Posterior pole field covering the optic disc and macula; camera: Topcon TRC-50DX: 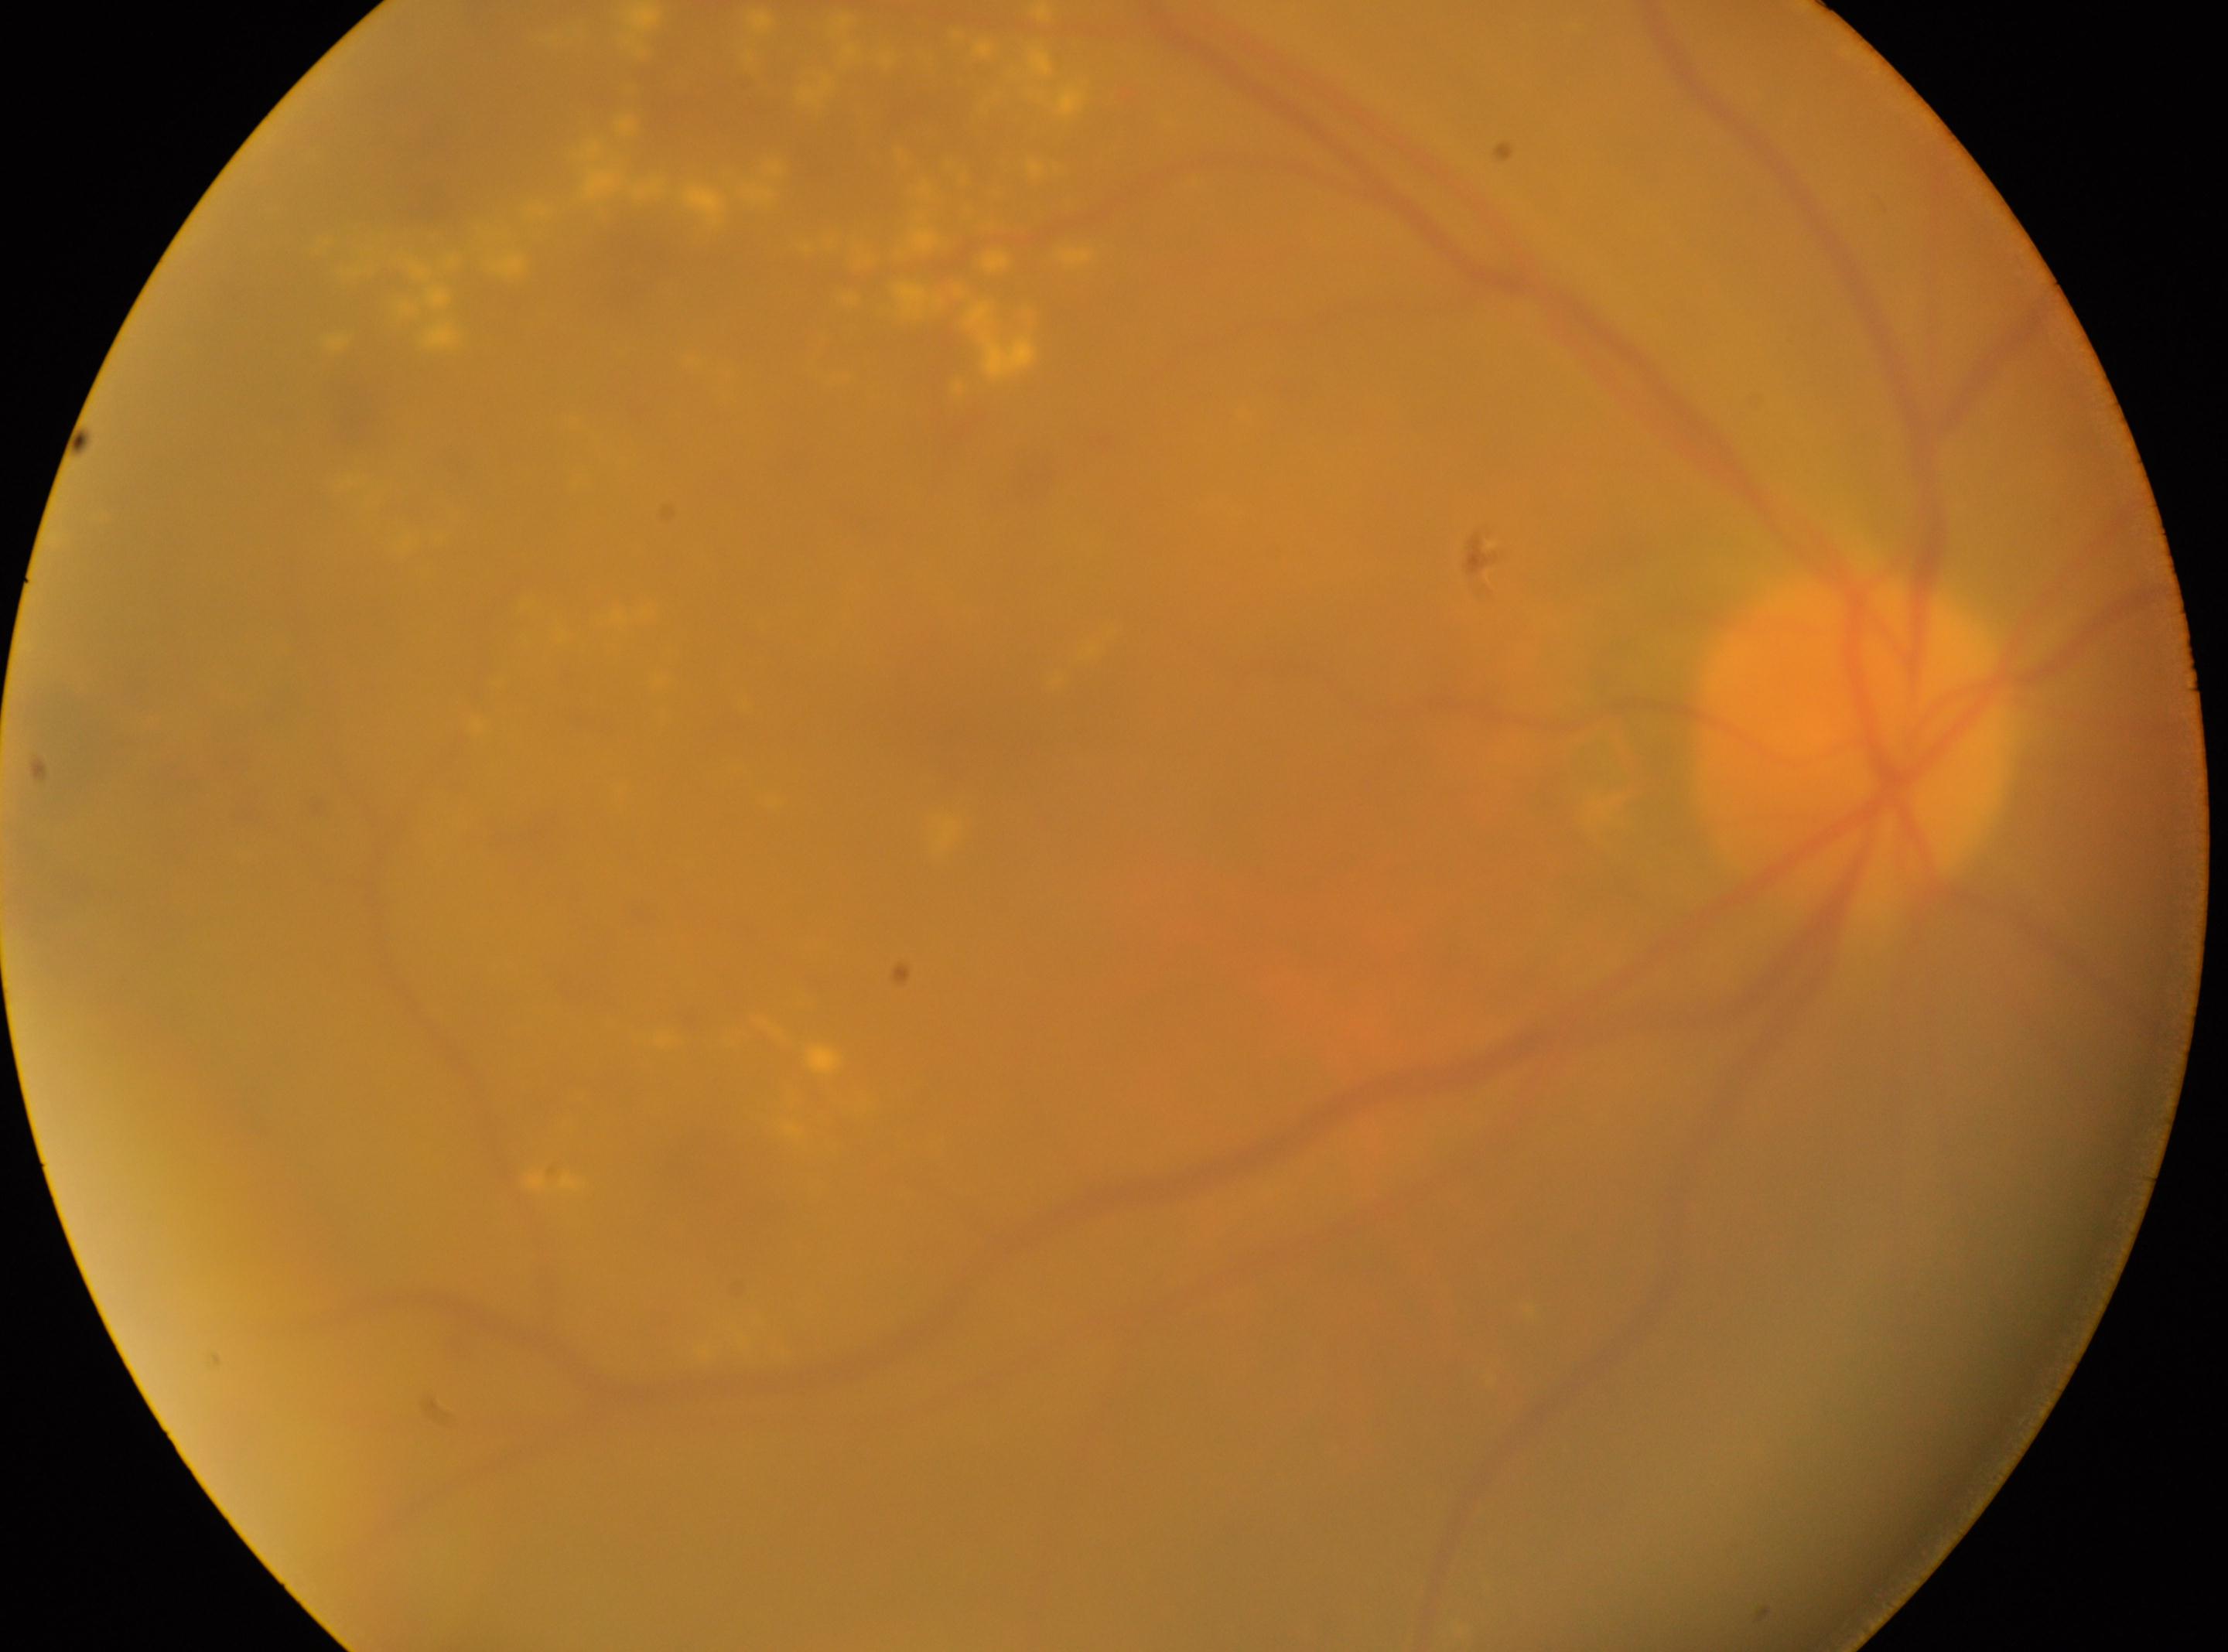
The fovea is at (964,715).
Optic disc located at (1850,743).
Retinopathy: 2/4.
This is the right eye.